1932 x 1932 pixels; captured after pupil dilation — 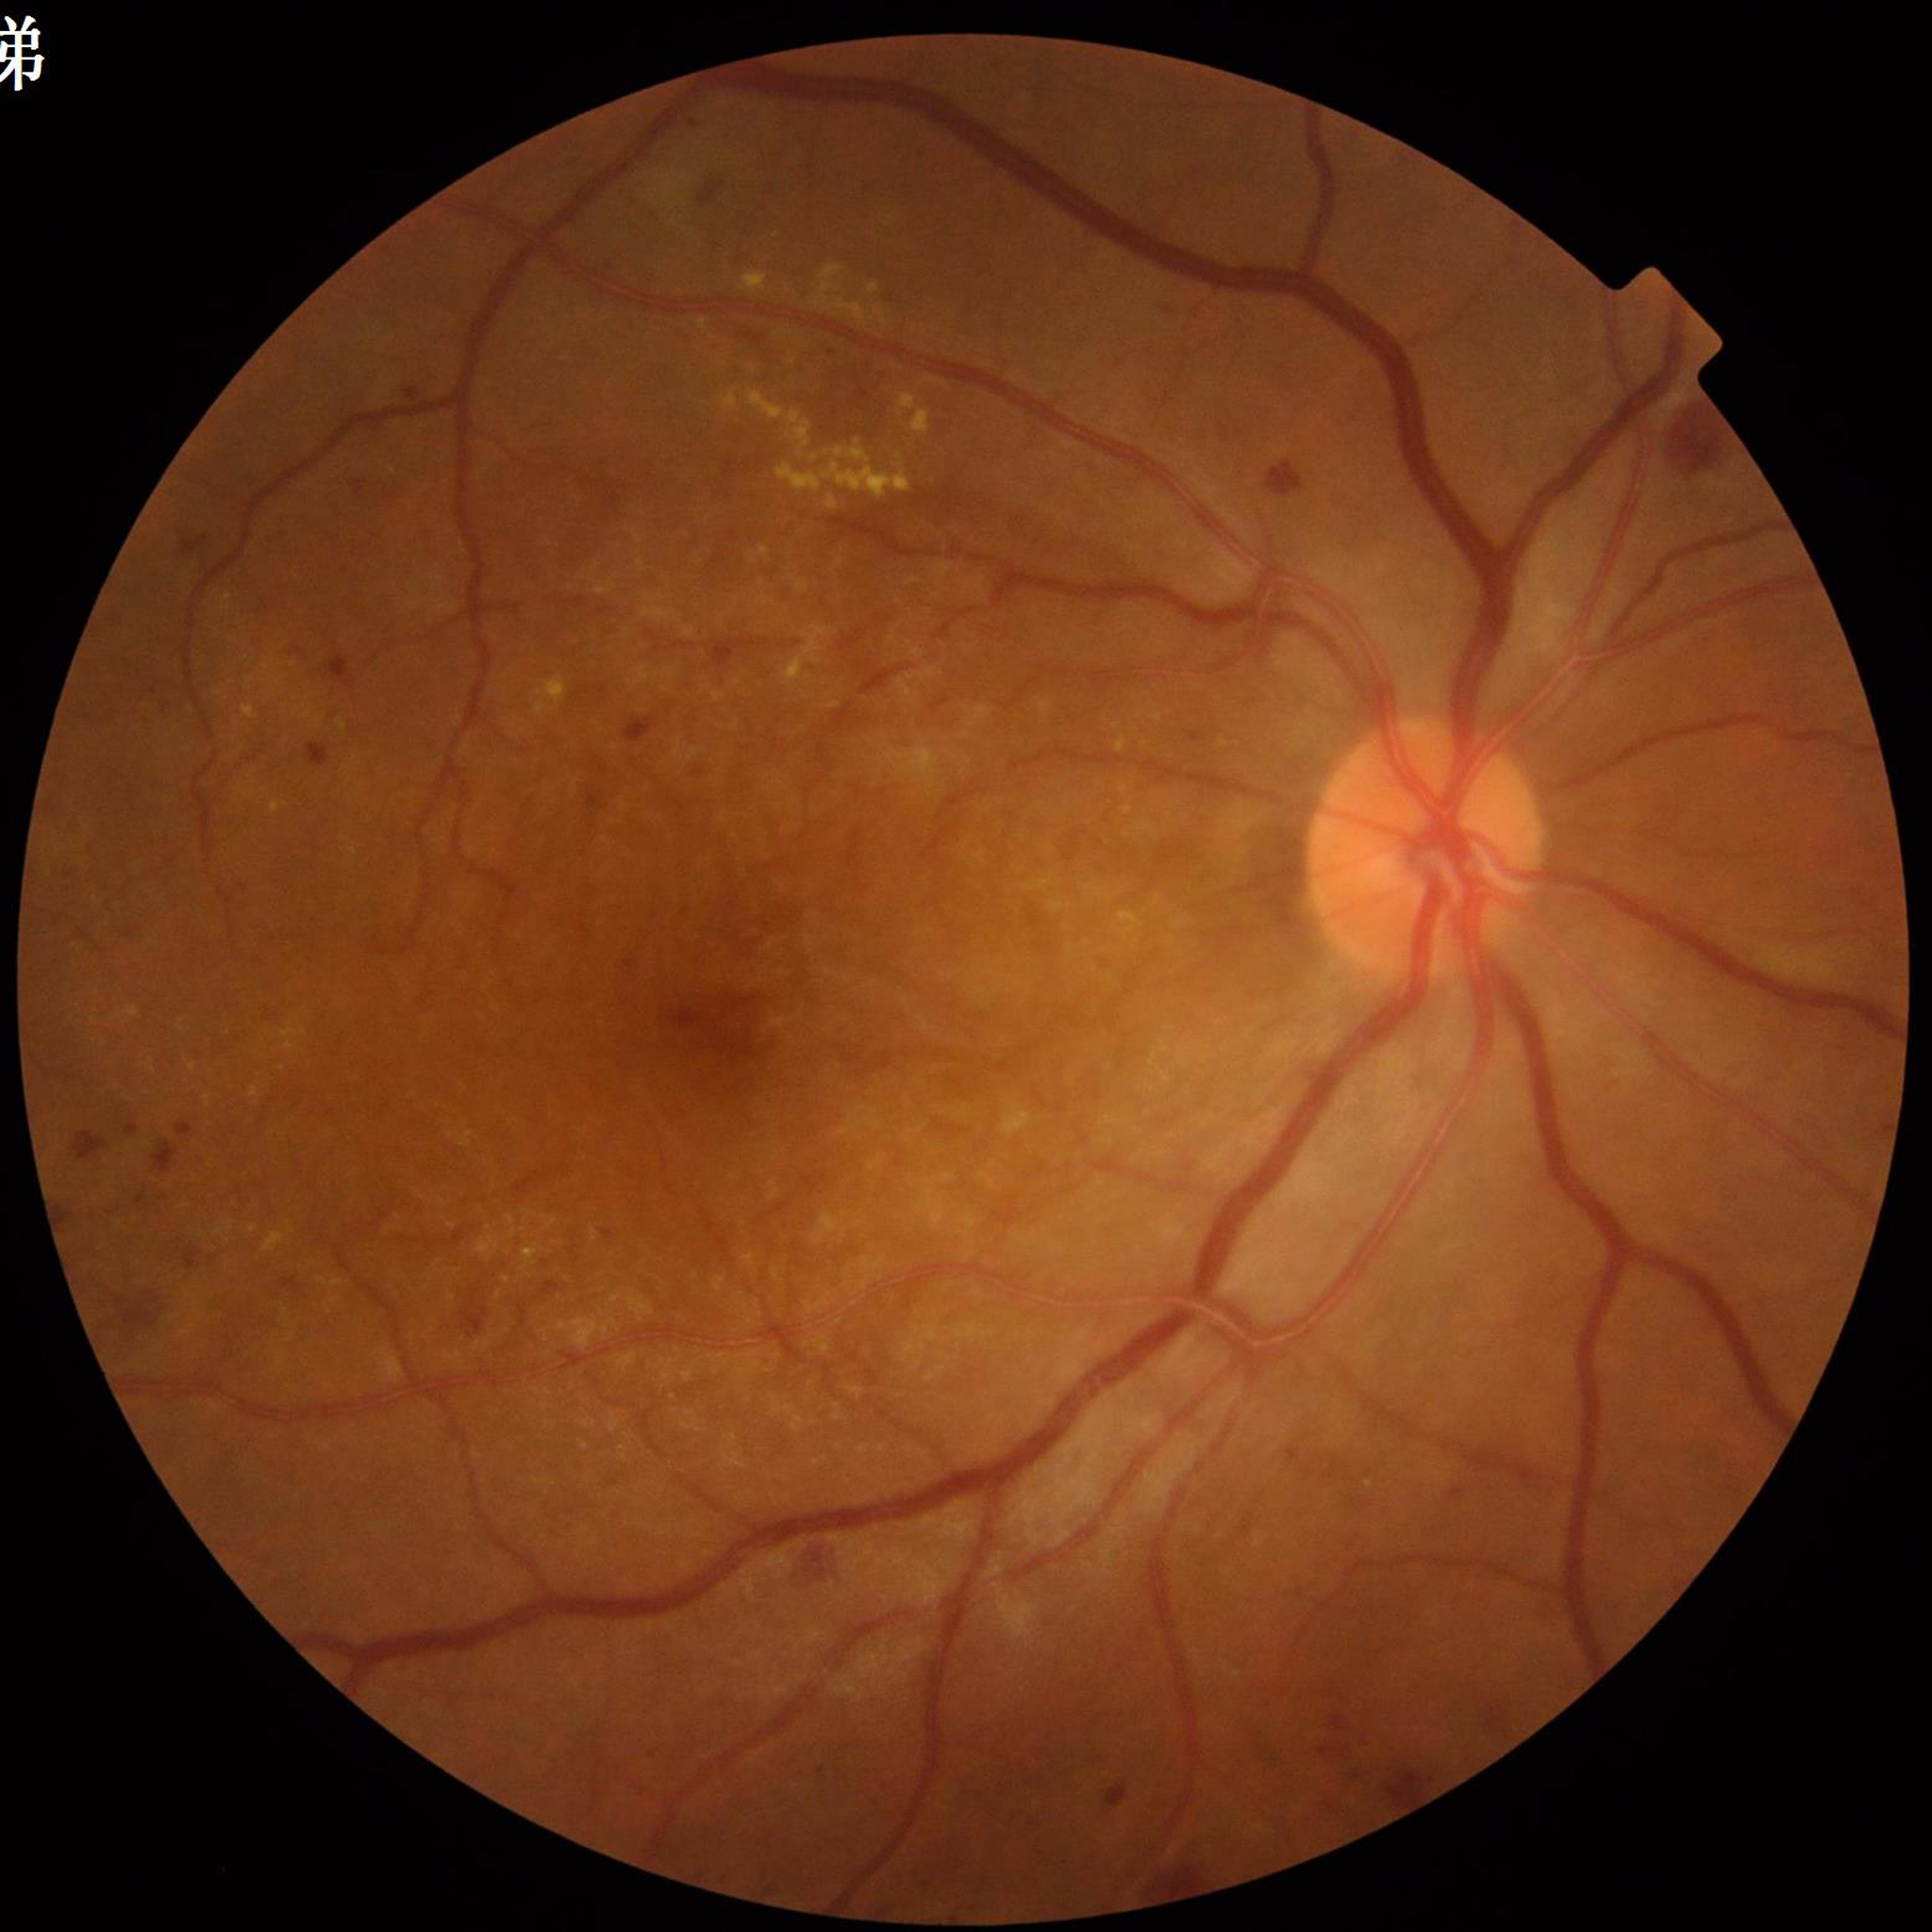
Fundus image of an eye with diabetic retinopathy.